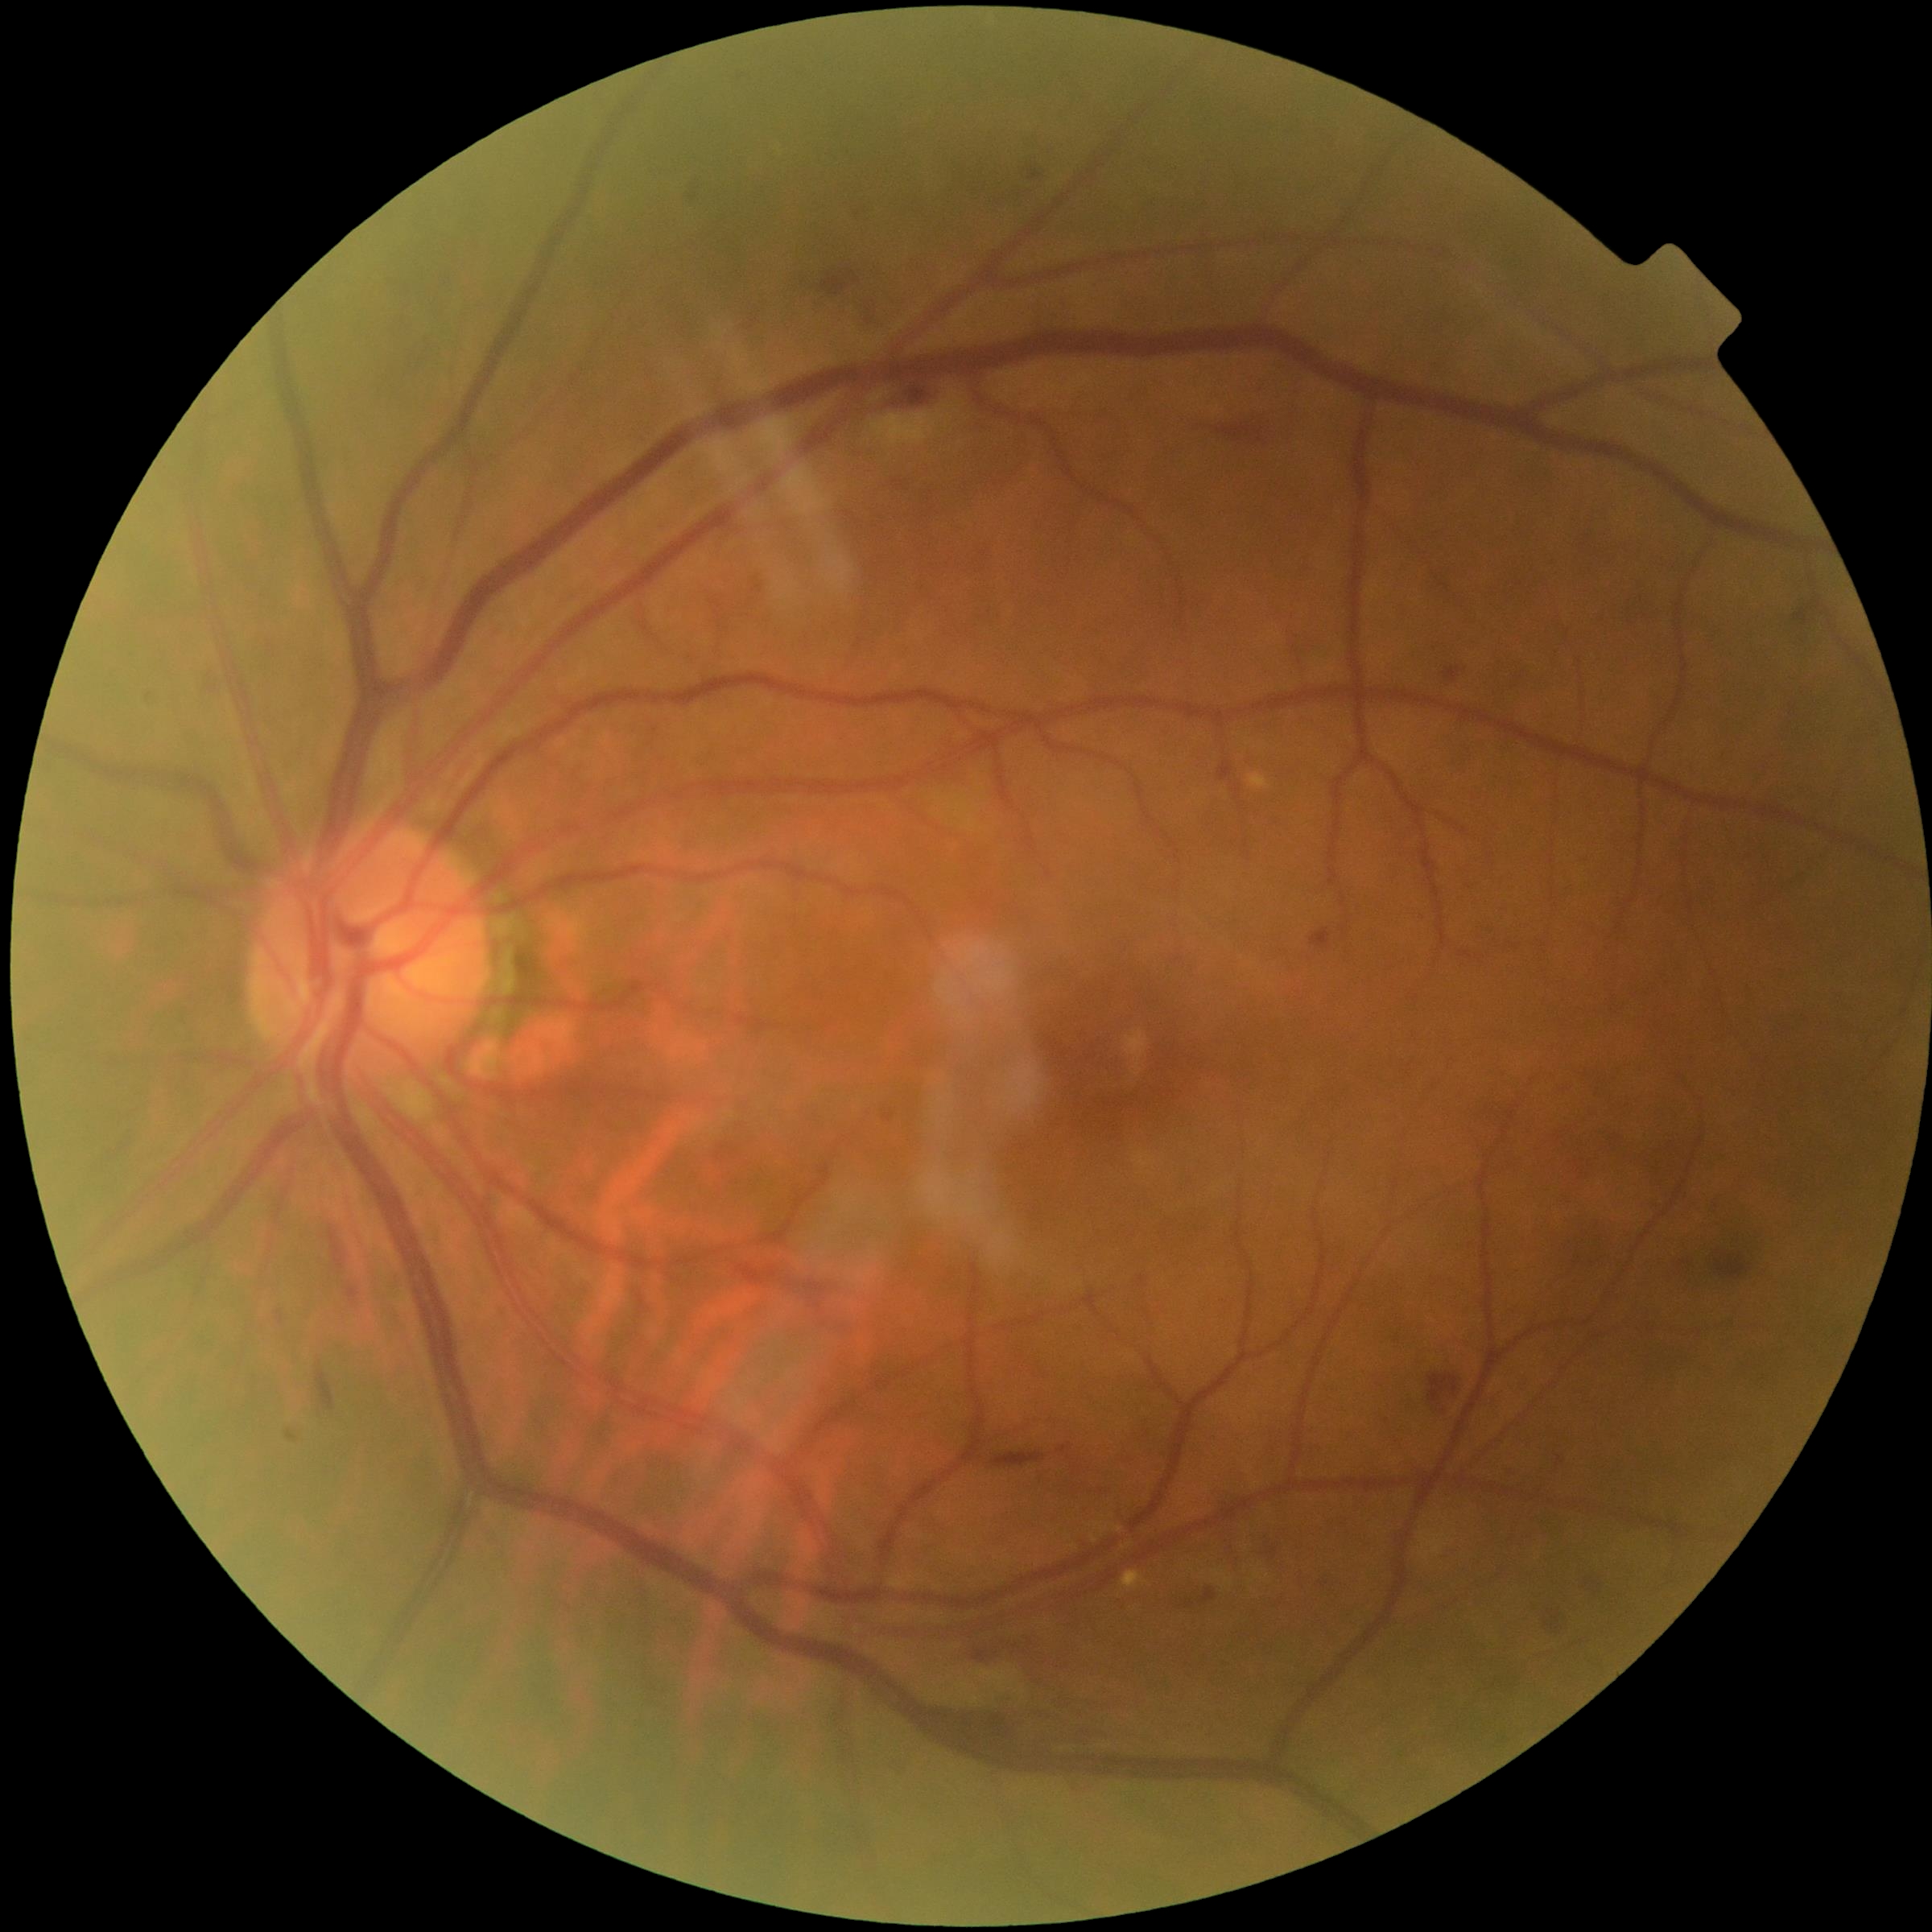

Diabetic retinopathy (DR) is grade 2
Representative lesions:
hemorrhages (HEs) (more not shown): left=1218, top=419, right=1276, bottom=437; left=990, top=1452, right=1046, bottom=1469; left=791, top=1300, right=835, bottom=1340; left=429, top=276, right=450, bottom=287; left=1426, top=1372, right=1469, bottom=1406; left=277, top=1311, right=284, bottom=1324; left=853, top=206, right=876, bottom=231; left=1794, top=597, right=1822, bottom=627; left=735, top=1265, right=844, bottom=1293; left=397, top=306, right=416, bottom=330; left=976, top=1644, right=1000, bottom=1657; left=316, top=1370, right=335, bottom=1411; left=194, top=660, right=217, bottom=685